Modified Davis classification:
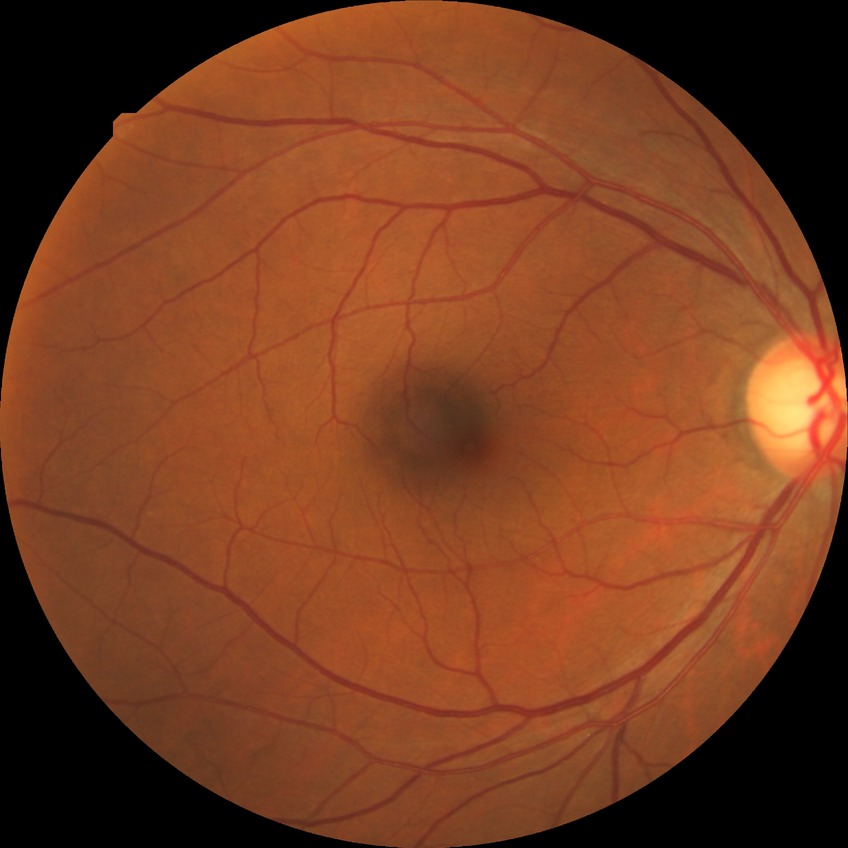 {"davis_grade": "SDR"}